Davis DR grading · nonmydriatic fundus photograph · NIDEK AFC-230 fundus camera · 848x848px
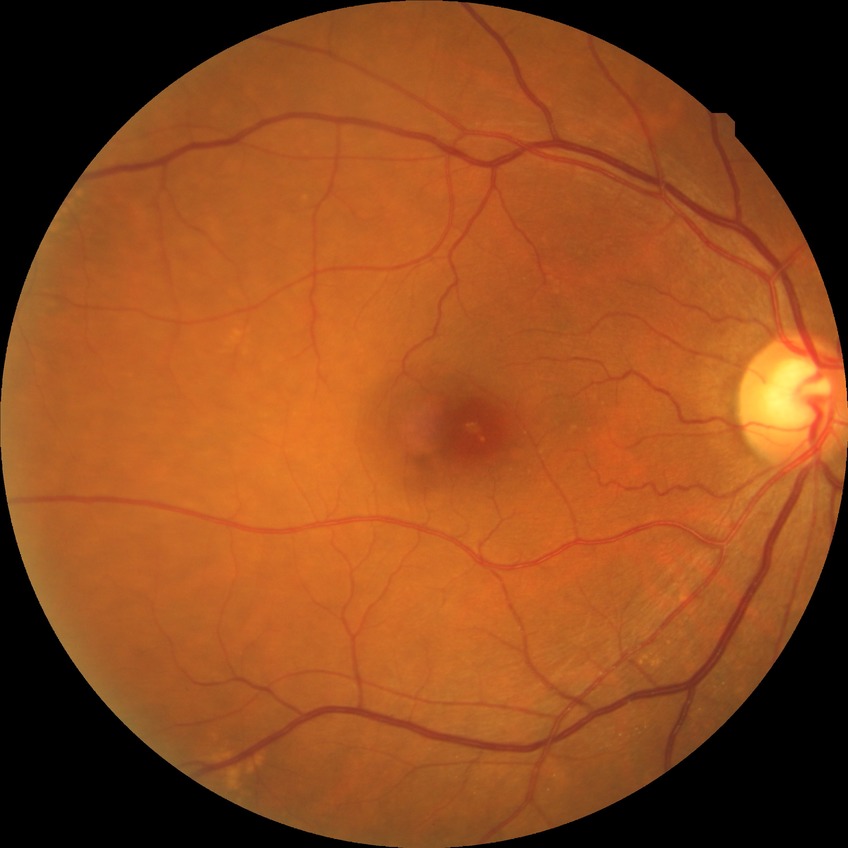 Retinopathy stage: no diabetic retinopathy.